Wide-field fundus image from infant ROP screening:
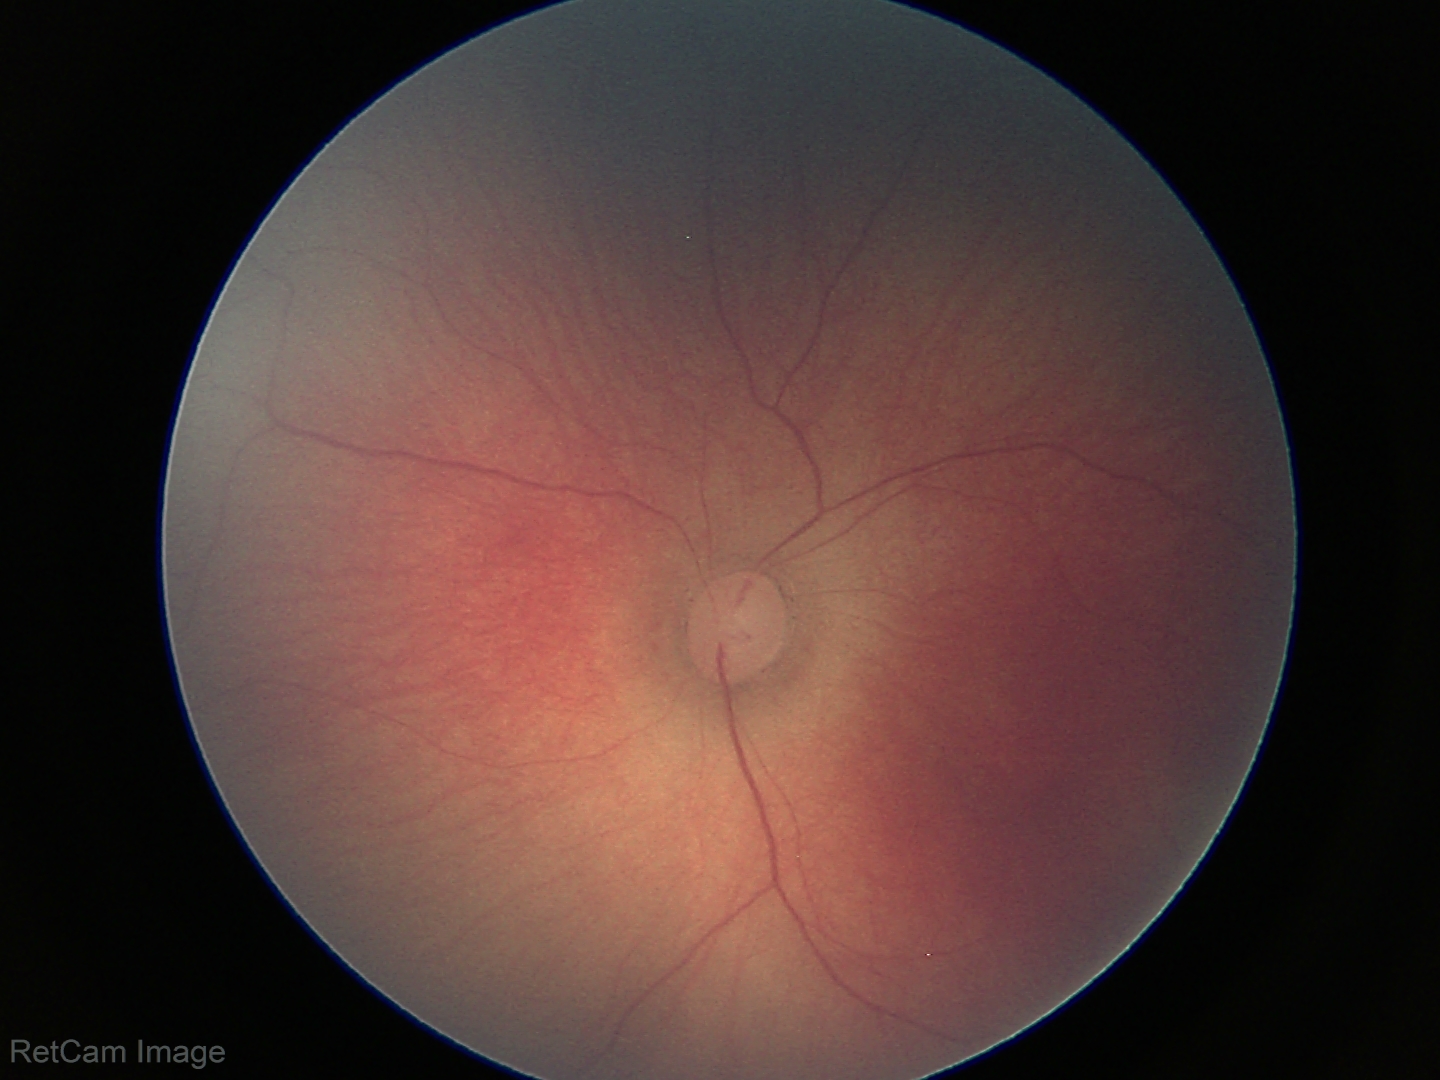 Plus disease absent. Examination diagnosed as ROP stage 1.